Image size 2352x1568. Retinal fundus photograph. 45° field of view — 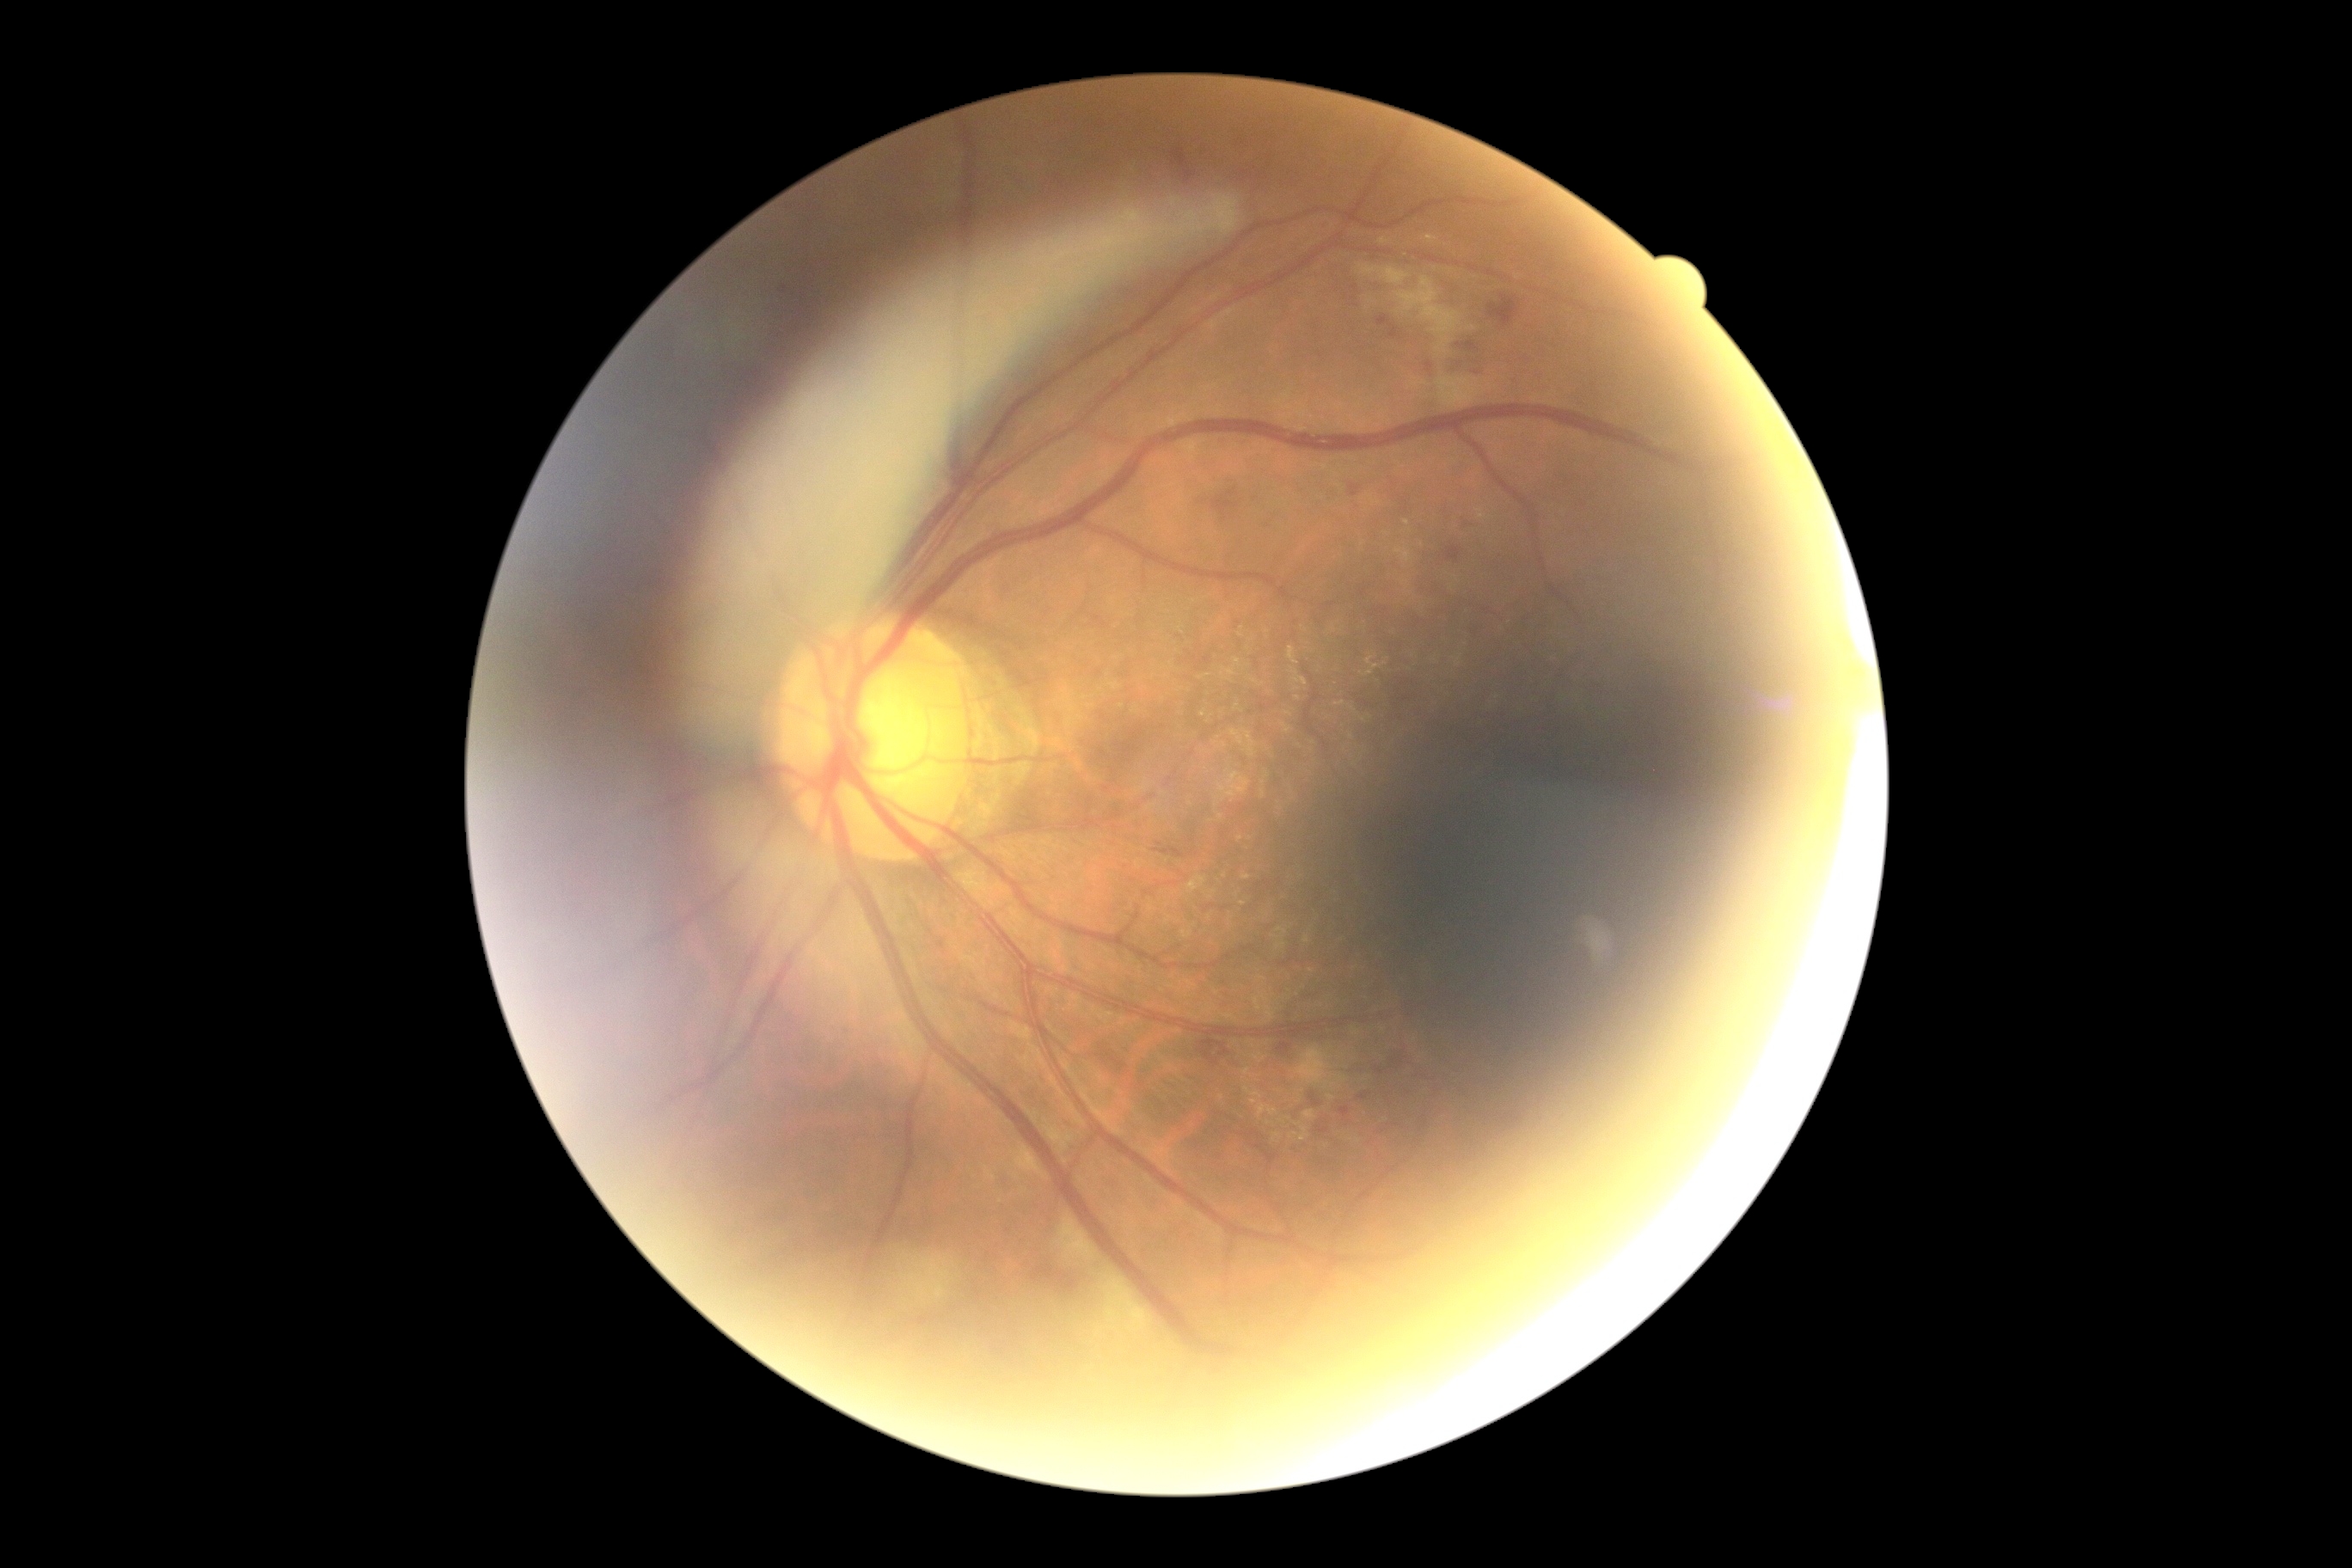 DR stage@moderate NPDR (grade 2) — more than just microaneurysms but less than severe NPDR.